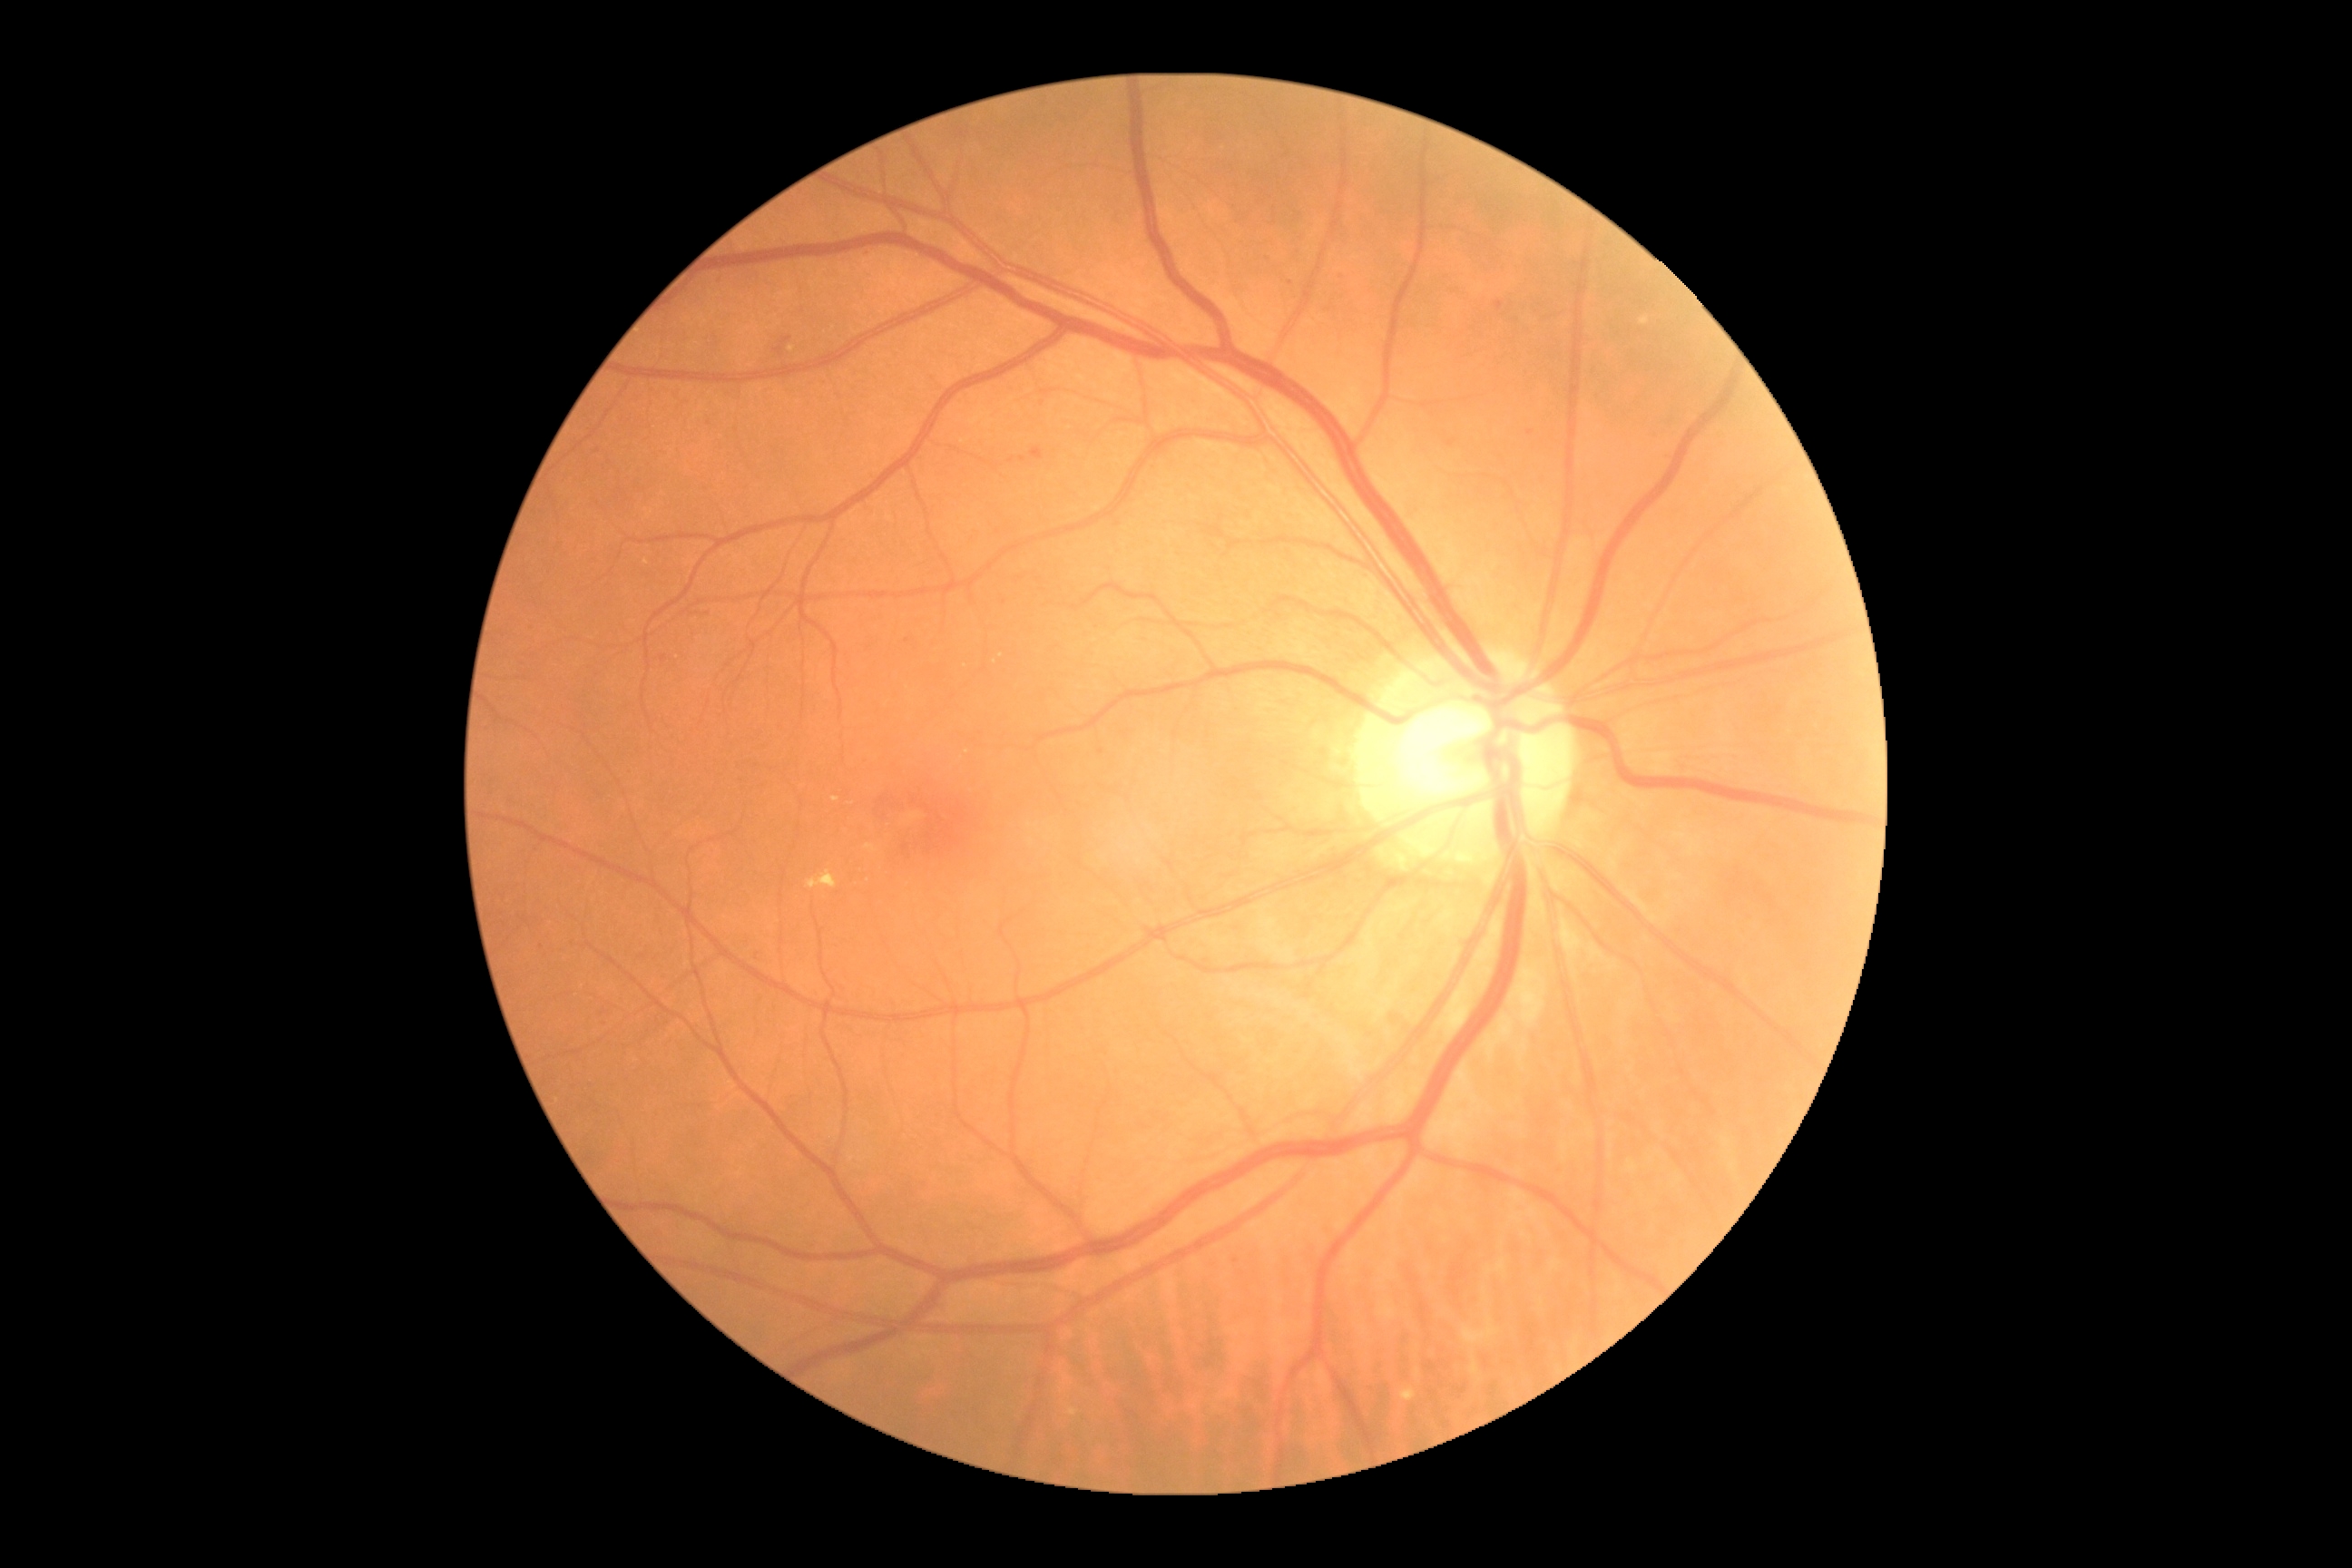
DR: grade 2 (moderate NPDR).